CFP. Image size 1932x1932. 45° field of view:
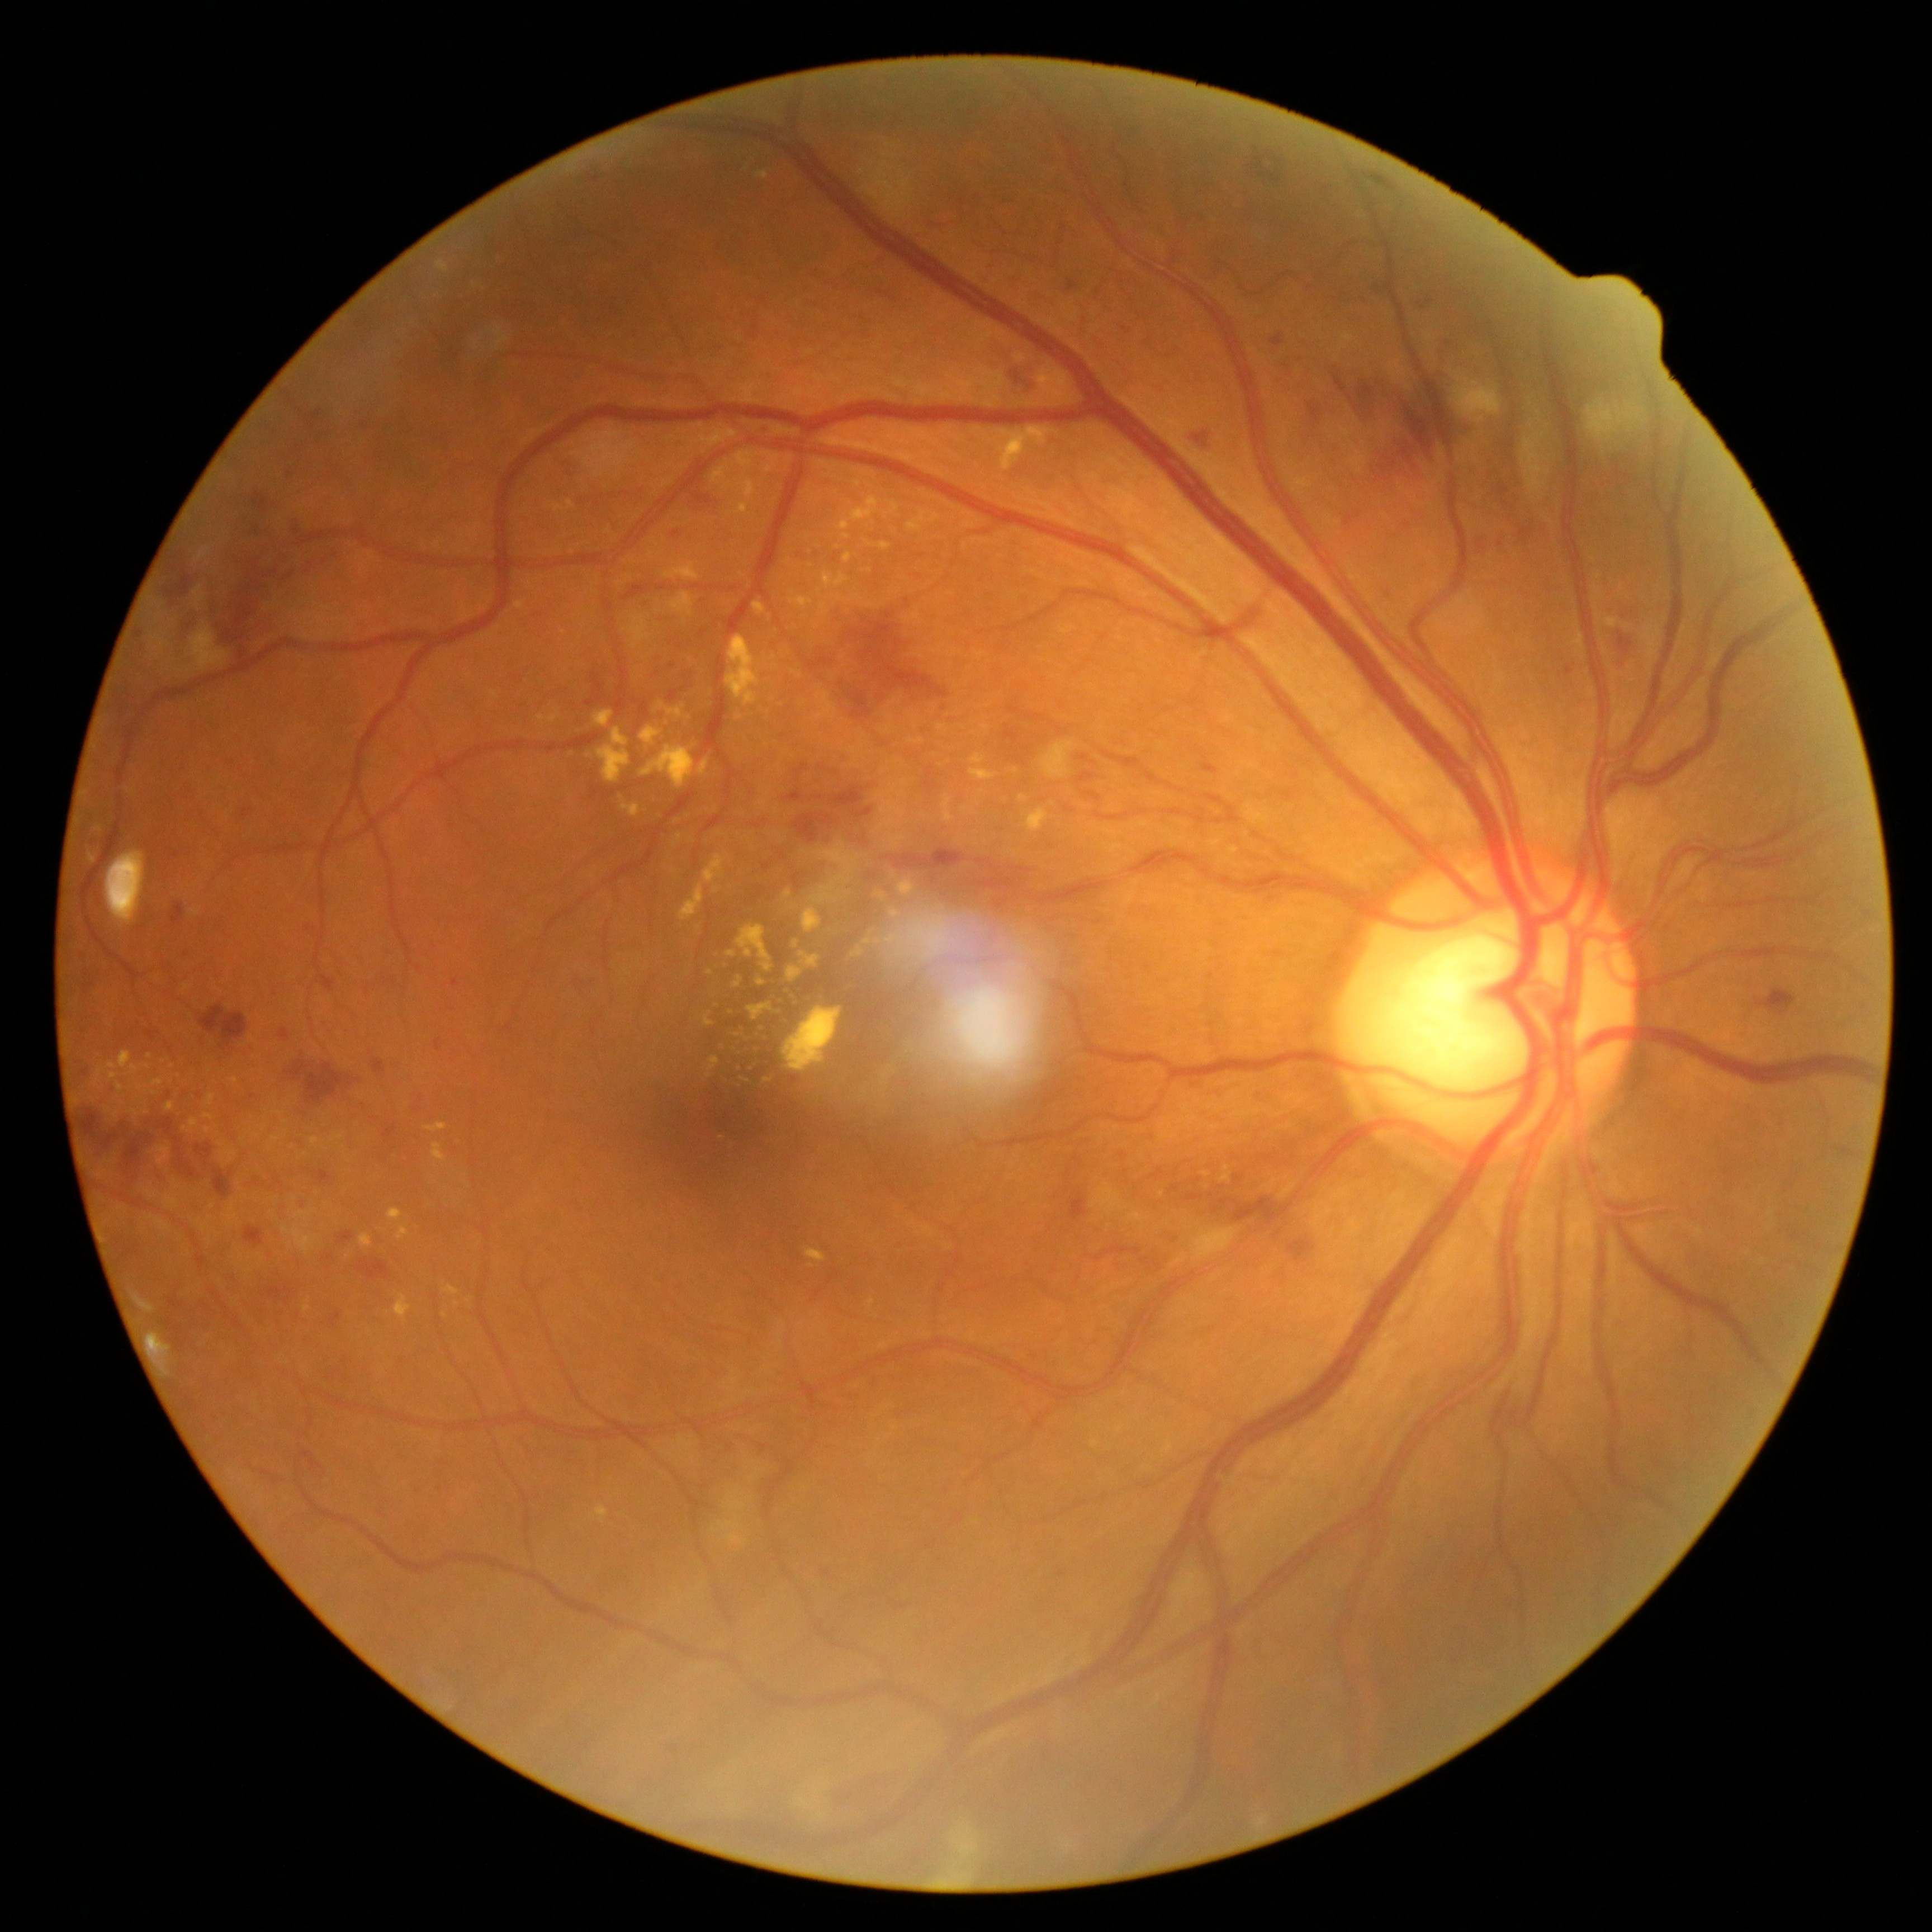

Retinopathy grade: 3
Selected lesions:
hard exudates (partial): <bbox>548, 713, 561, 723</bbox> | <bbox>741, 1030, 745, 1038</bbox> | <bbox>819, 602, 829, 619</bbox> | <bbox>566, 500, 575, 509</bbox> | <bbox>838, 497, 879, 539</bbox> | <bbox>462, 279, 480, 291</bbox> | <bbox>709, 1057, 719, 1072</bbox> | <bbox>232, 1077, 240, 1085</bbox> | <bbox>787, 965, 802, 984</bbox> | <bbox>822, 571, 849, 590</bbox> | <bbox>273, 1112, 281, 1115</bbox> | <bbox>223, 1151, 238, 1158</bbox> | <bbox>711, 451, 781, 501</bbox> | <bbox>258, 1126, 267, 1131</bbox>
Small hard exudates near x=590, y=757 | x=179, y=1077 | x=164, y=1063 | x=778, y=1013
hemorrhages (partial): <bbox>146, 1030, 155, 1038</bbox> | <bbox>75, 1107, 211, 1183</bbox> | <bbox>244, 1227, 264, 1246</bbox> | <bbox>831, 787, 864, 810</bbox> | <bbox>338, 1232, 355, 1245</bbox> | <bbox>200, 1006, 249, 1048</bbox> | <bbox>793, 764, 810, 775</bbox> | <bbox>1186, 1195, 1204, 1204</bbox> | <bbox>844, 1778, 897, 1807</bbox> | <bbox>1363, 173, 1397, 193</bbox> | <bbox>166, 1088, 182, 1094</bbox> | <bbox>1079, 773, 1095, 782</bbox> | <bbox>693, 491, 711, 506</bbox> | <bbox>1251, 151, 1283, 184</bbox> | <bbox>1171, 1230, 1180, 1234</bbox> | <bbox>950, 860, 1036, 894</bbox> | <bbox>172, 905, 185, 926</bbox> | <bbox>268, 1287, 295, 1301</bbox> | <bbox>213, 1171, 234, 1198</bbox>